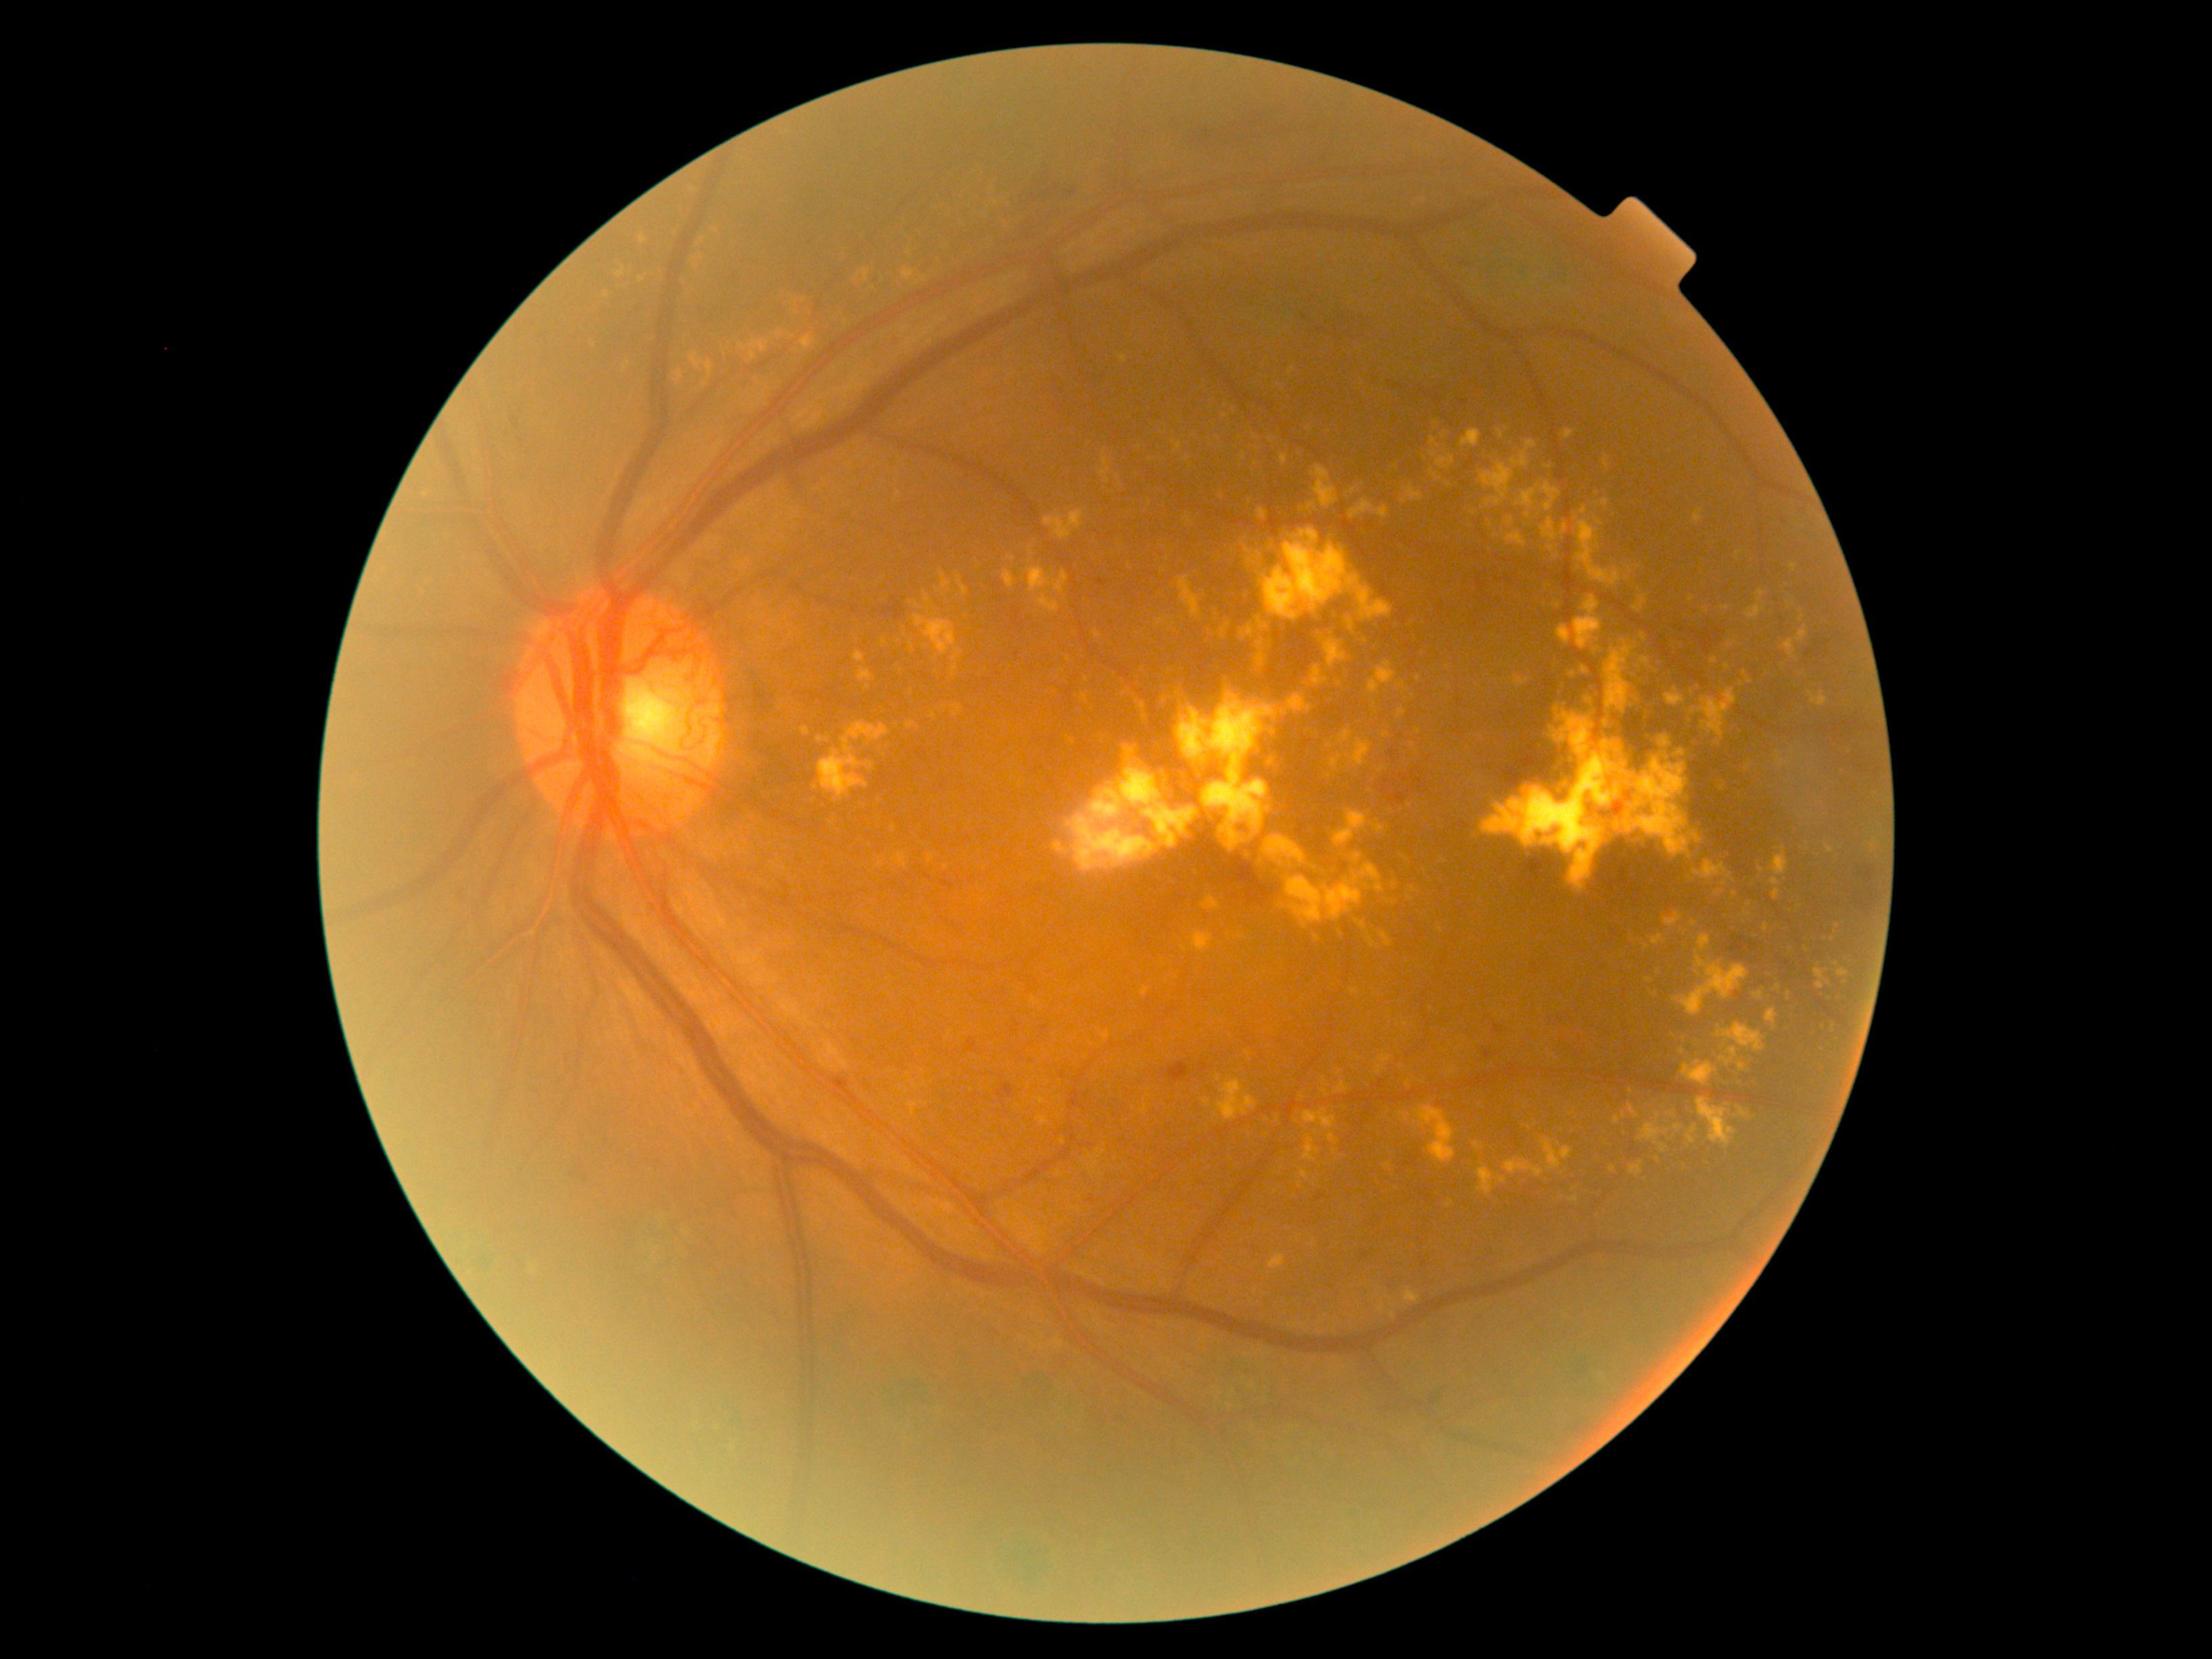

Diabetic retinopathy (DR) is grade 4 (PDR)
Lesions identified (partial list):
hard exudates (EXs) (continued) = 1683/1061/1718/1086; 1604/455/1610/468; 1497/1177/1507/1184; 1294/1115/1303/1127; 1507/533/1527/547; 1665/688/1685/708; 1826/845/1833/853; 1269/1112/1283/1123; 1784/640/1797/657; 1414/1105/1455/1165; 1811/1036/1817/1044; 928/855/933/863; 775/331/785/340
Smaller EXs around [607, 295]; [1731, 646]; [1162, 595]; [1381, 769]; [1623, 1135]; [1339, 684]; [1410, 899]